Camera: NIDEK AFC-230; no pharmacologic dilation.
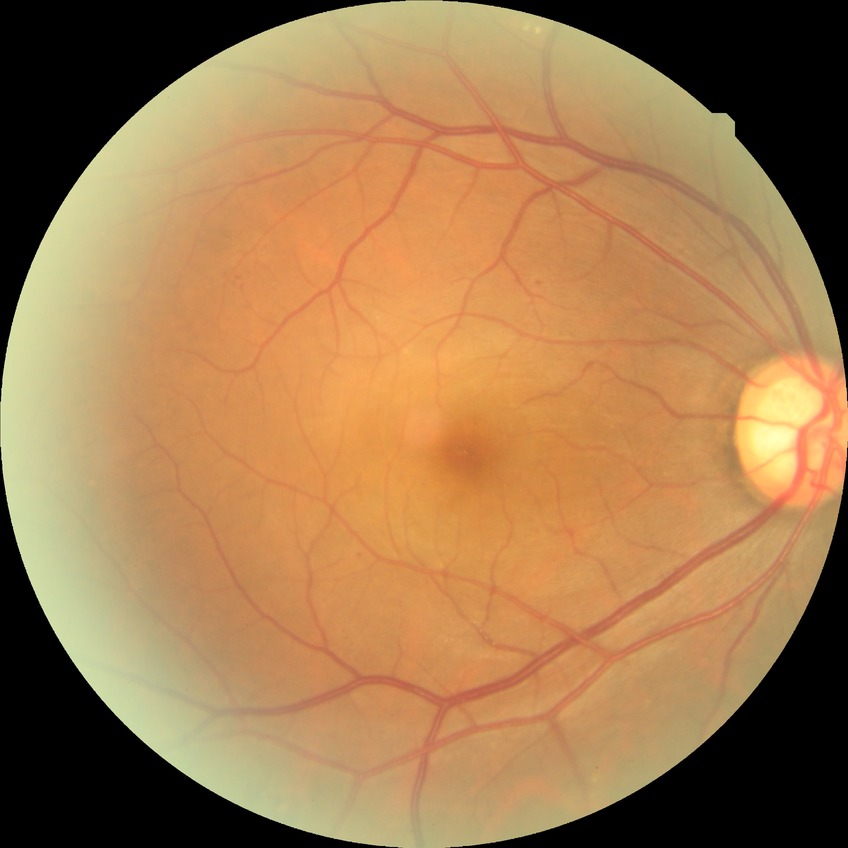
Diabetic retinopathy (DR): PPDR (pre-proliferative diabetic retinopathy). DR class: non-proliferative diabetic retinopathy.